Phoenix ICON, 100° FOV · infant wide-field fundus photograph:
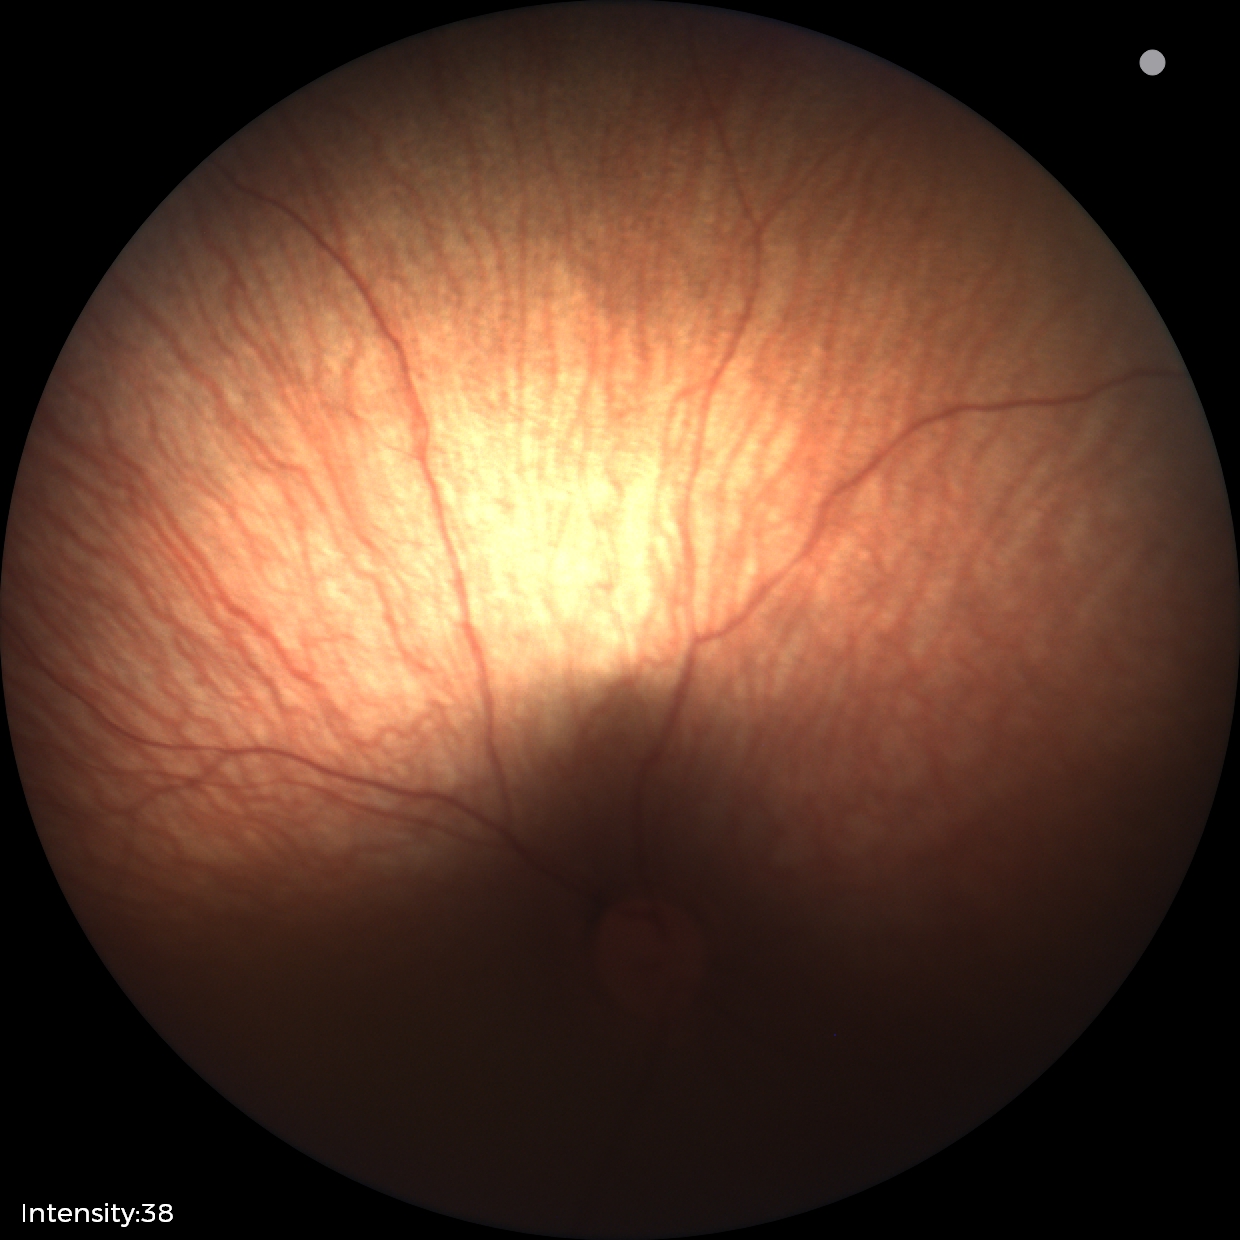
Examination with physiological retinal findings.